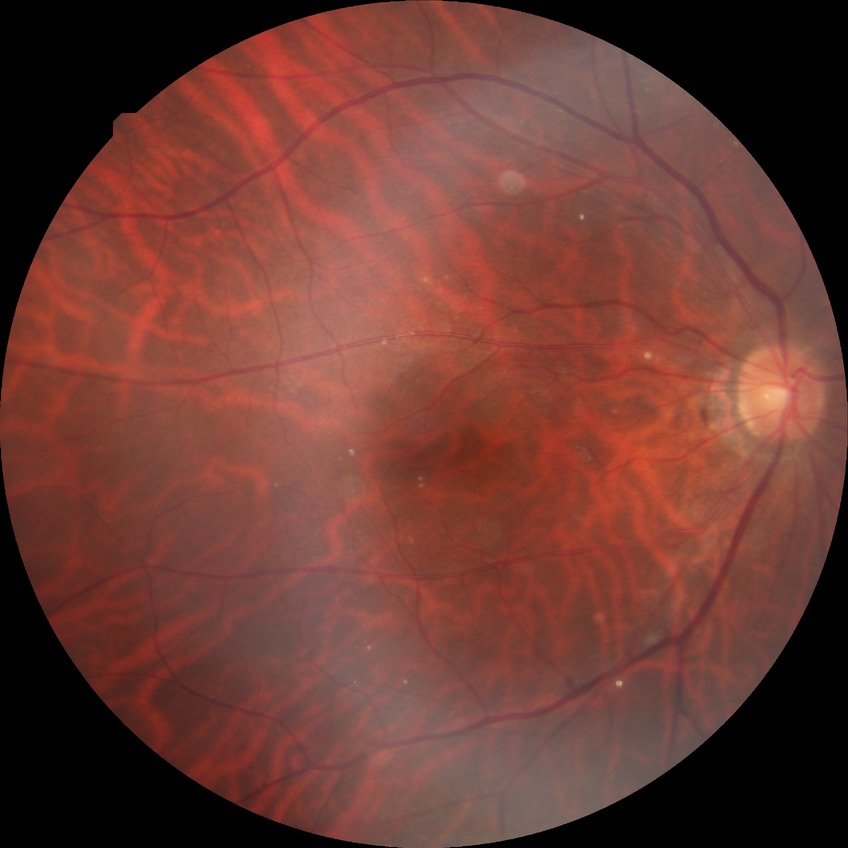 Retinopathy stage: no diabetic retinopathy.